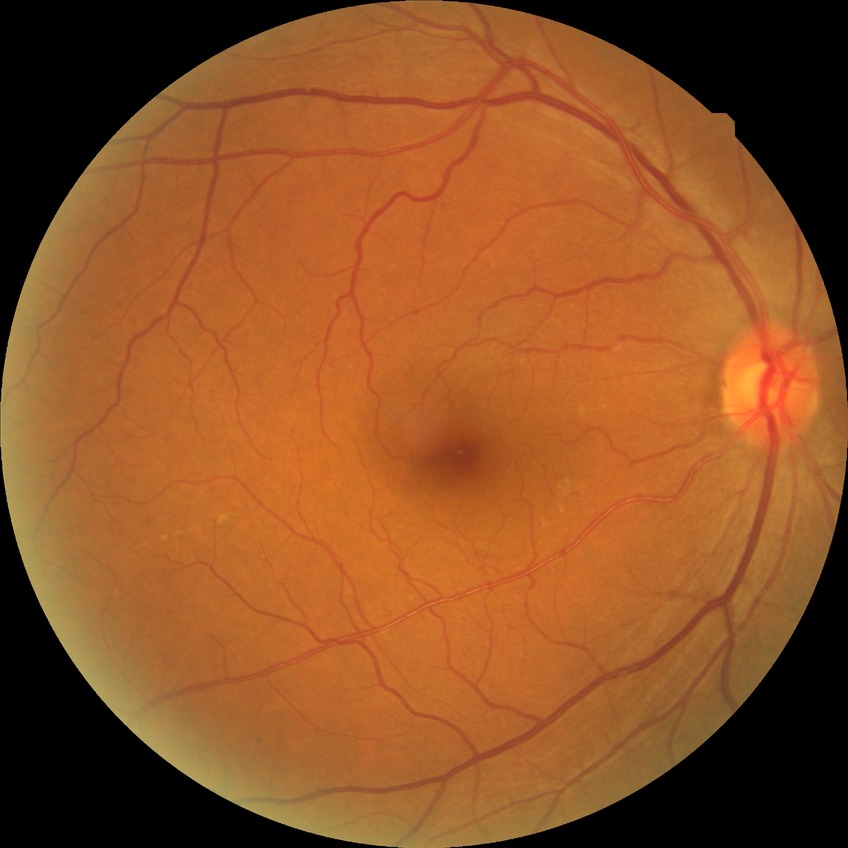 diabetic retinopathy severity: no diabetic retinopathy